Wide-field contact fundus photograph of an infant. Clarity RetCam 3, 130° FOV:
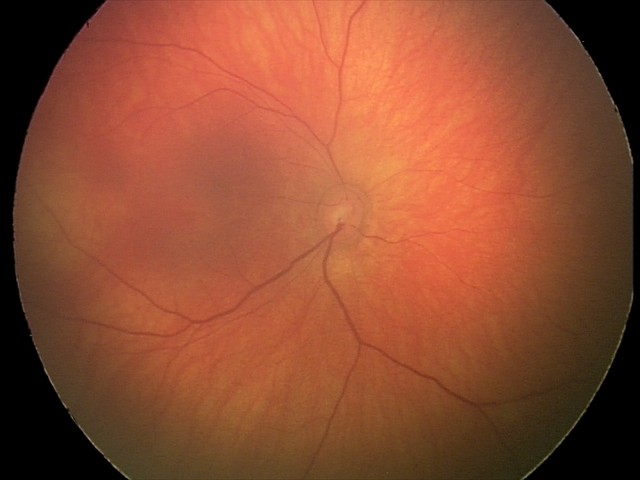
Diagnosis from this screening exam: retinal hemorrhages.